45° FOV
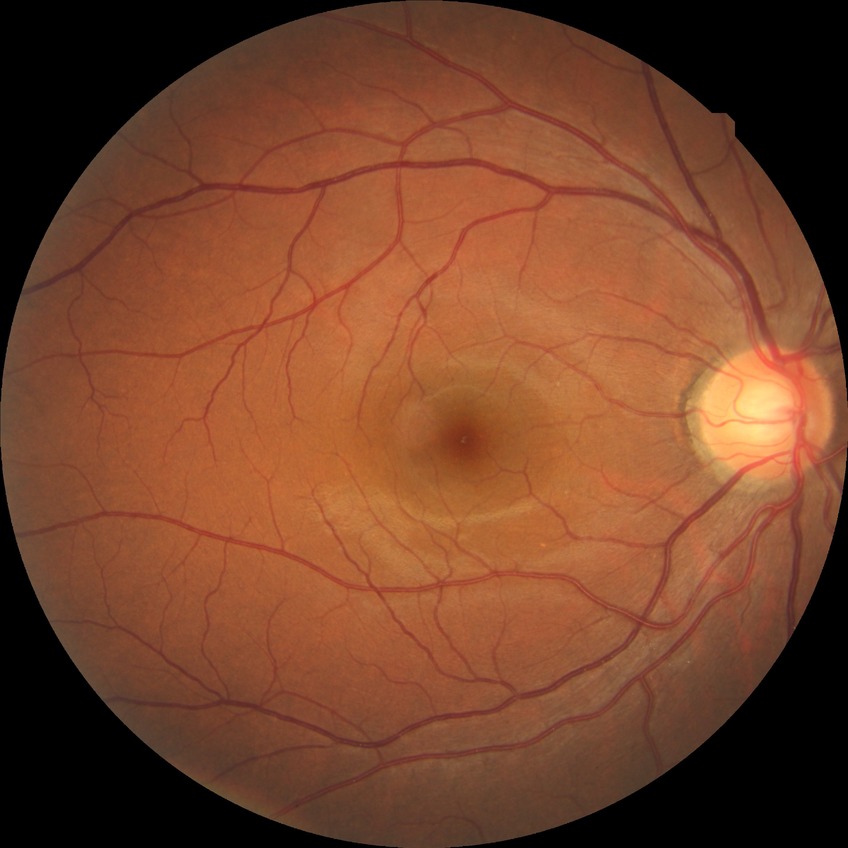   davis_grade: no diabetic retinopathy (NDR)